45° FOV, posterior pole photograph, DR severity per modified Davis staging — 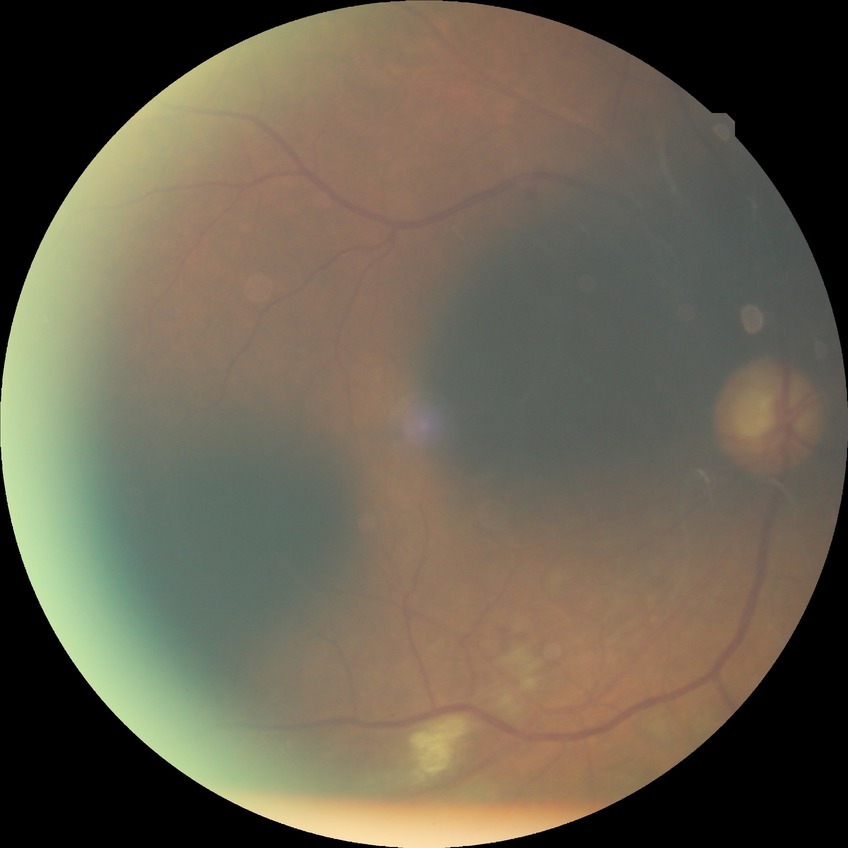

Diabetic retinopathy (DR): pre-proliferative diabetic retinopathy (PPDR).